Camera: Phoenix ICON (100° FOV); wide-field contact fundus photograph of an infant: 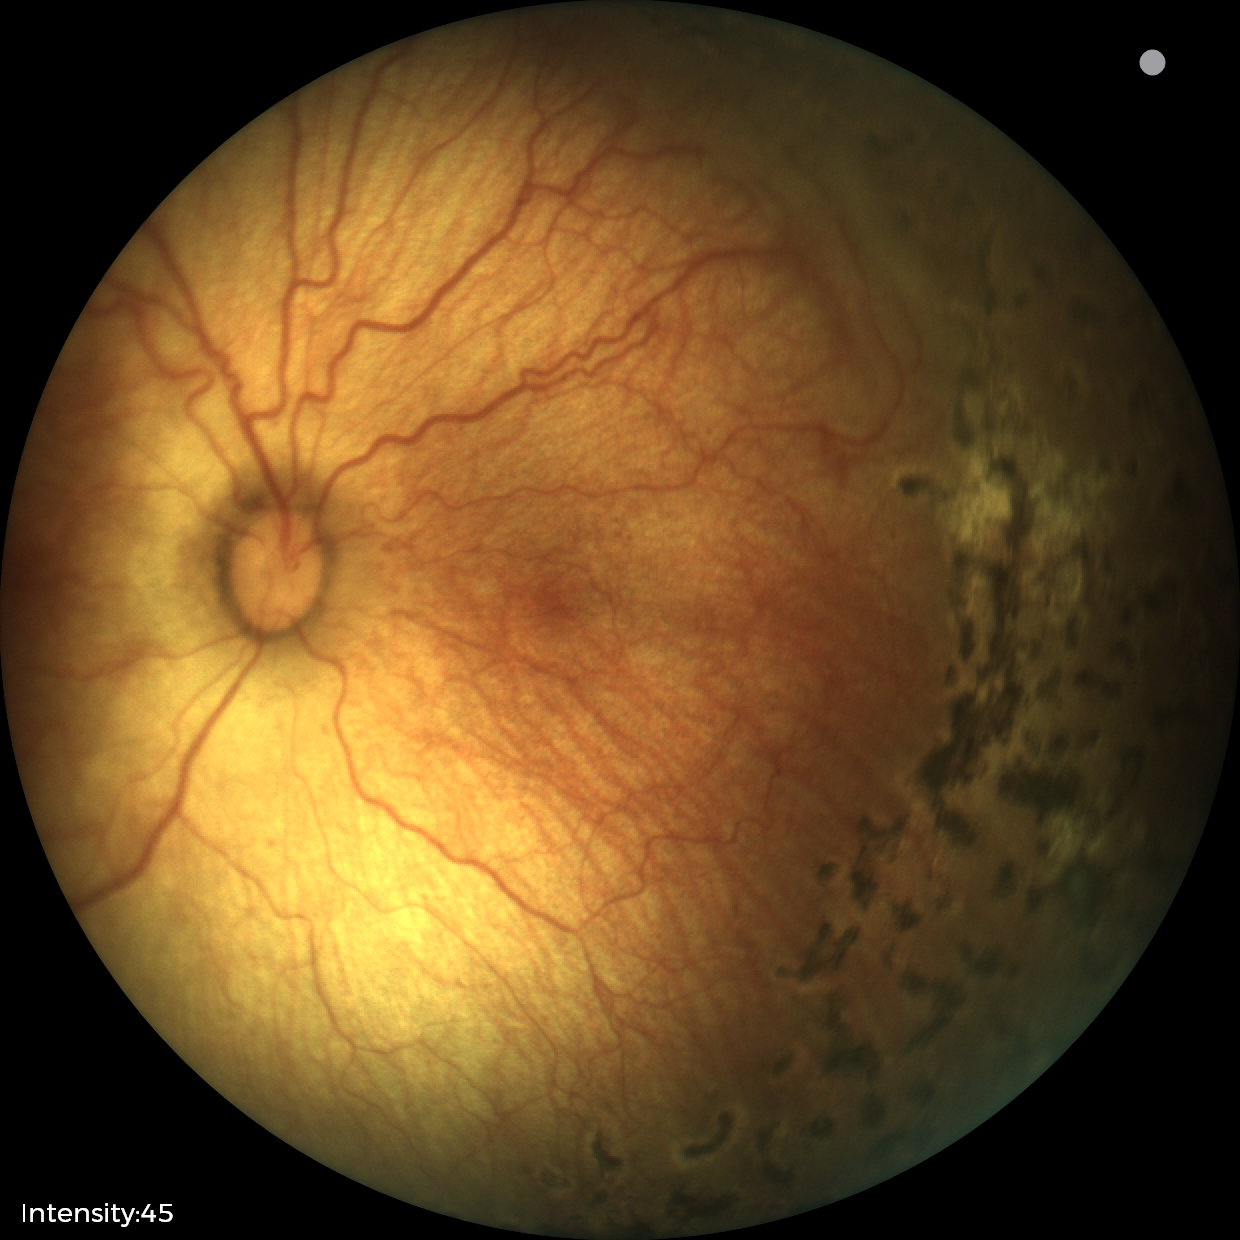

Examination diagnosed as status post ROP. Plus disease absent.